Wide-field fundus photograph from neonatal ROP screening:
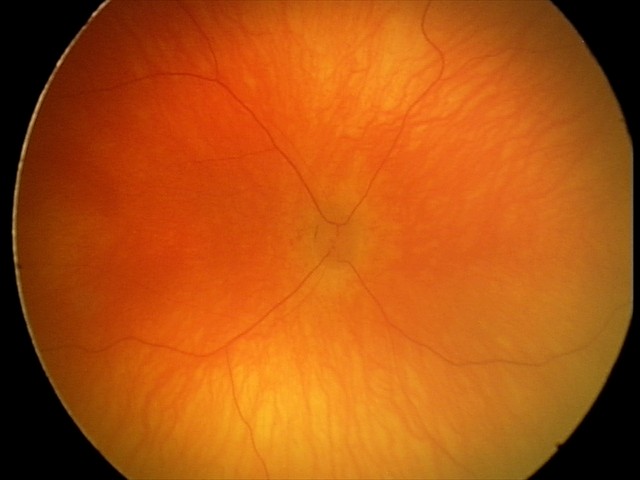
Diagnosis = normal retinal appearance